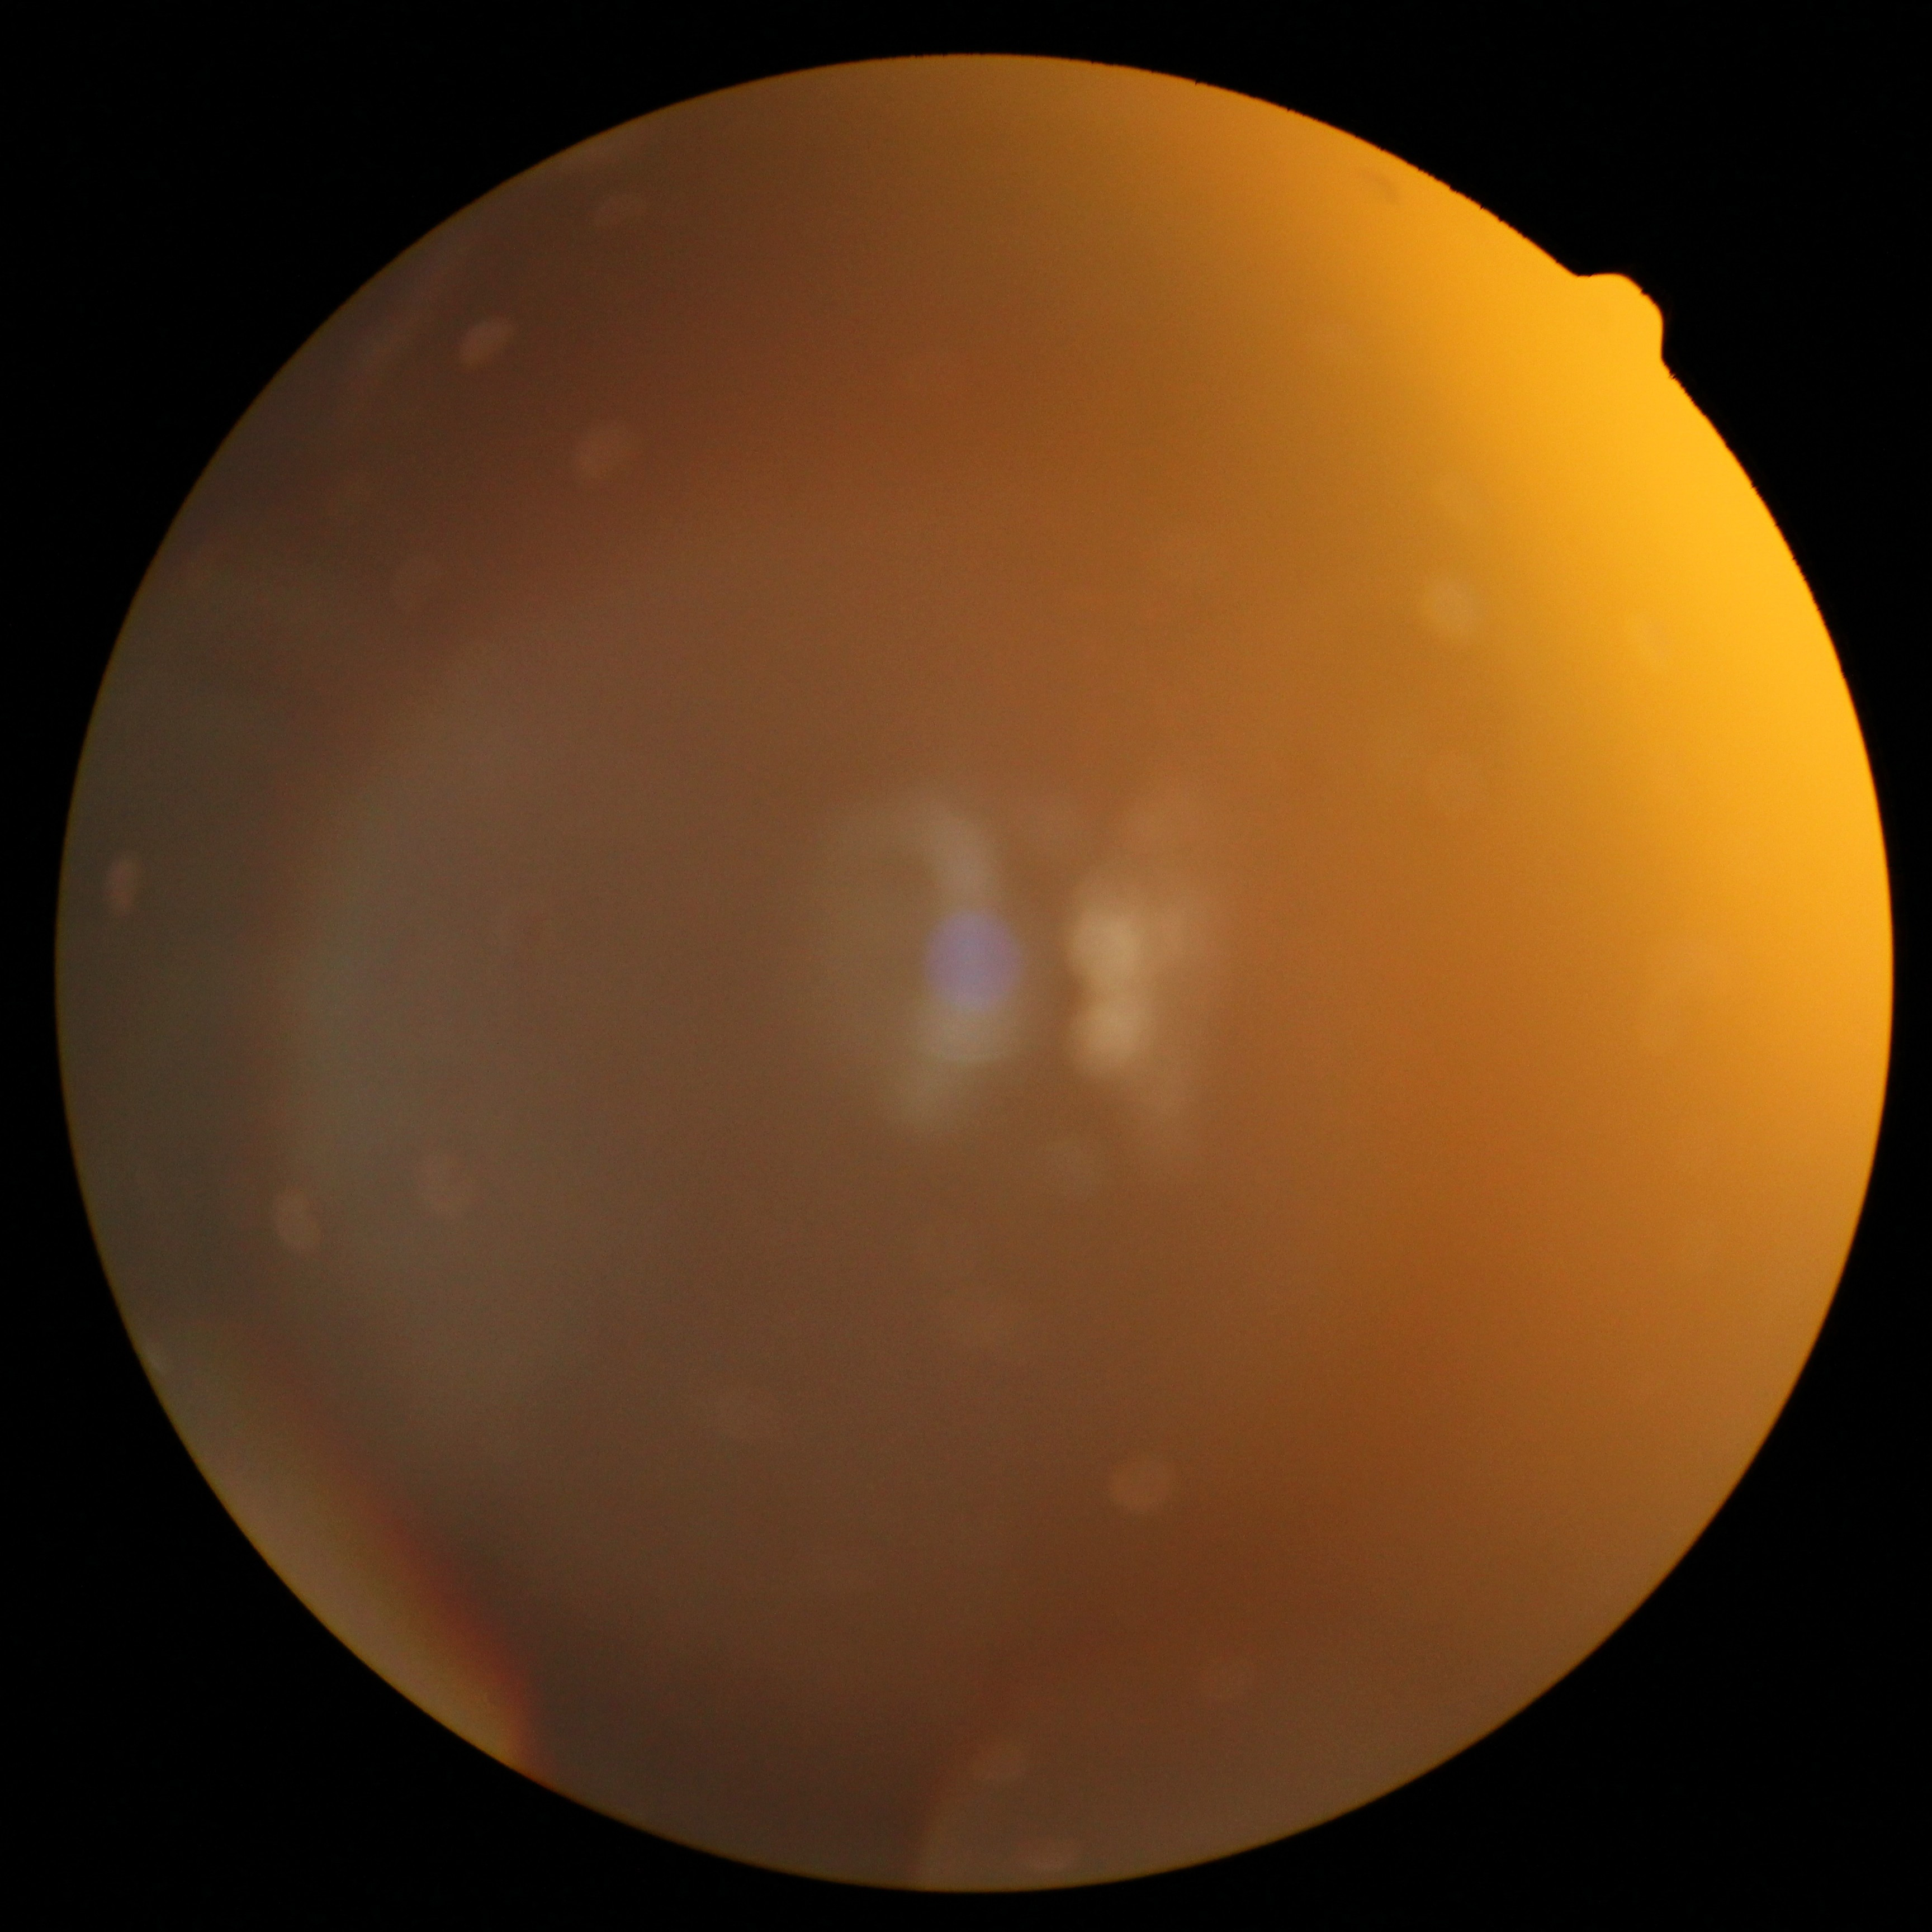

Ungradable image — DR severity cannot be determined.
DR is ungradable.